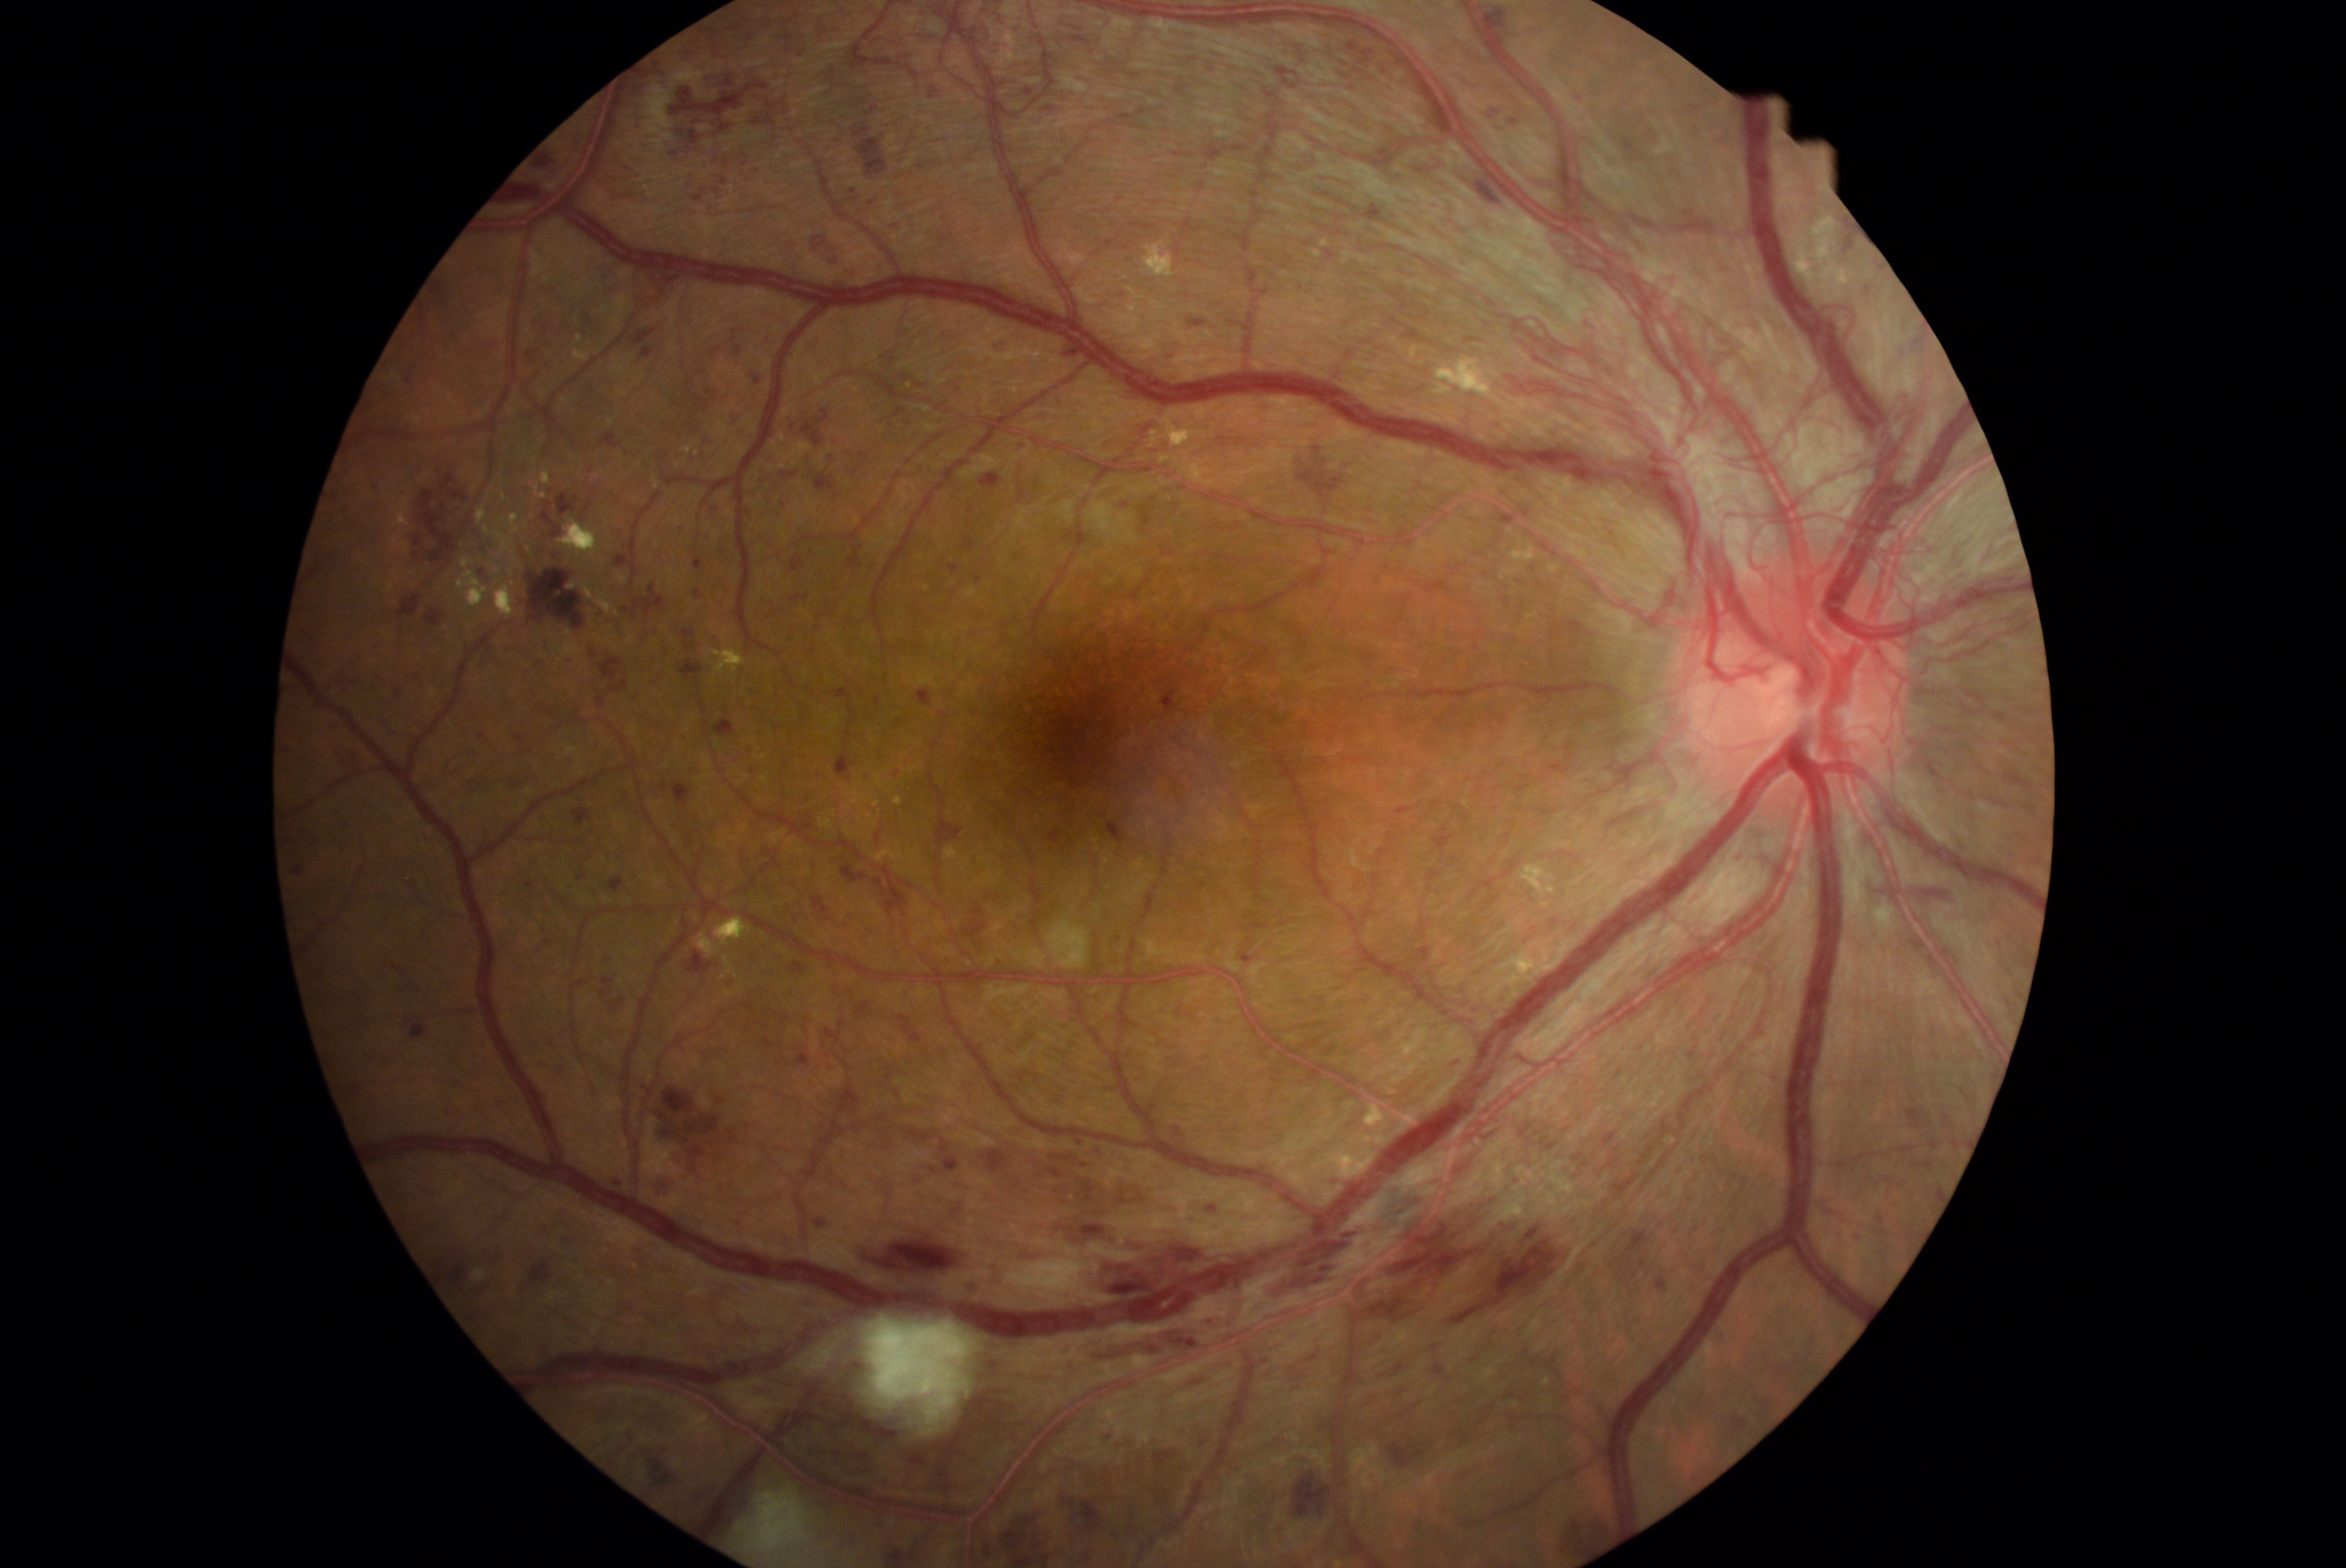
Diabetic retinopathy (DR) is 4
Selected lesions:
hemorrhages (HEs) (continued): 1364, 198, 1385, 216 | 611, 998, 626, 1009 | 1019, 440, 1030, 452 | 557, 492, 579, 517 | 724, 159, 730, 167 | 913, 1177, 923, 1186 | 1237, 1470, 1276, 1522 | 747, 371, 764, 385 | 711, 338, 732, 360 | 937, 818, 965, 844 | 887, 1547, 902, 1552 | 990, 339, 1012, 352 | 1944, 1114, 1952, 1128 | 1102, 437, 1127, 449 | 641, 346, 655, 360 | 526, 567, 587, 630 | 1484, 101, 1525, 129
HEs (small, approximate centers) near [1112,1550] | [1908,1038]